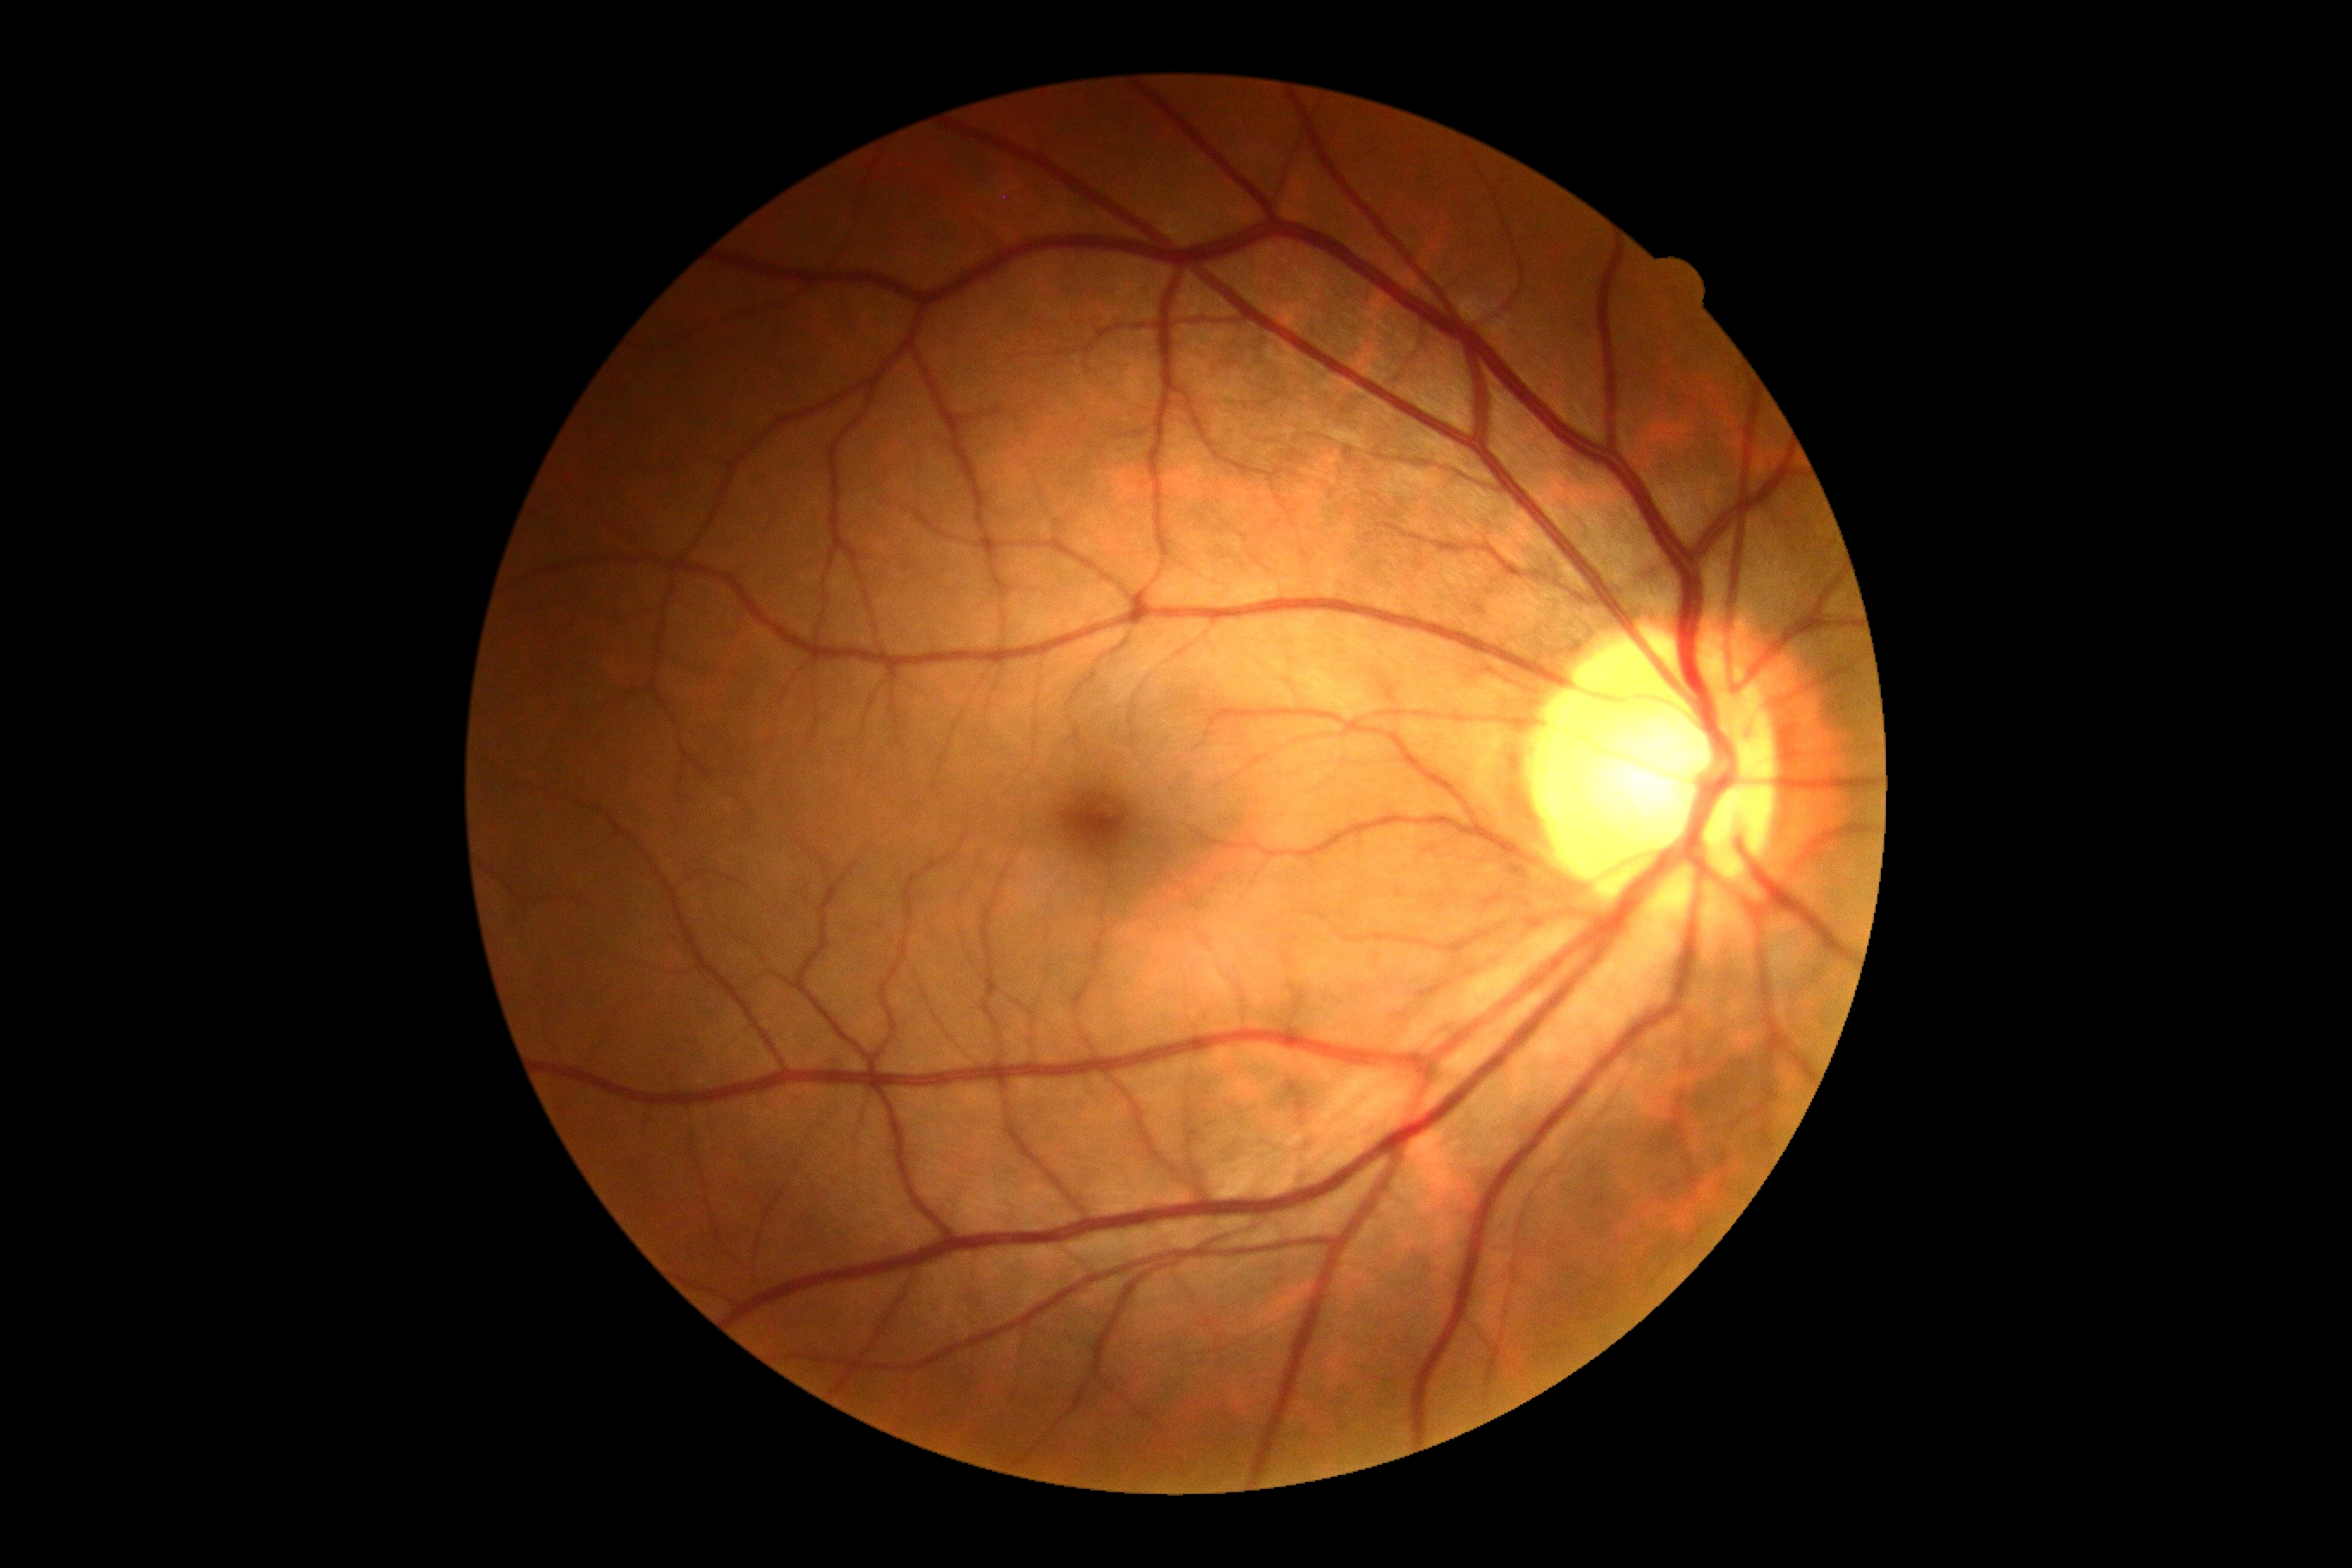 Diabetic retinopathy: grade 0.